45-degree field of view · 848x848px.
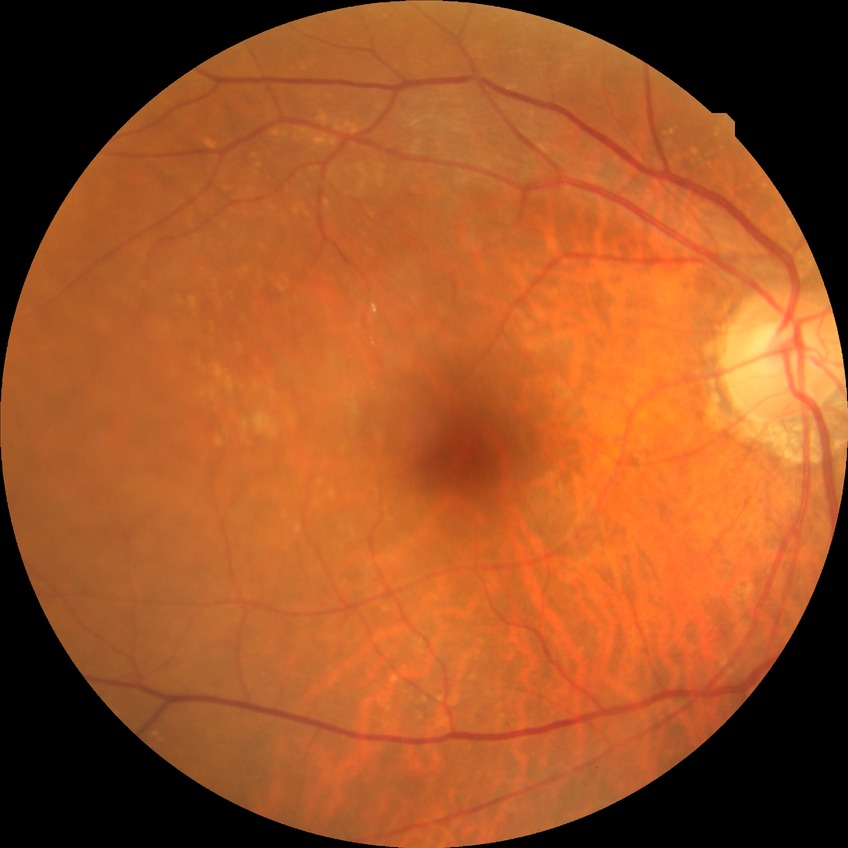
davis_grade: no diabetic retinopathy